CFP, 1659x2212px, acquired with a Remidio Fundus on Phone.
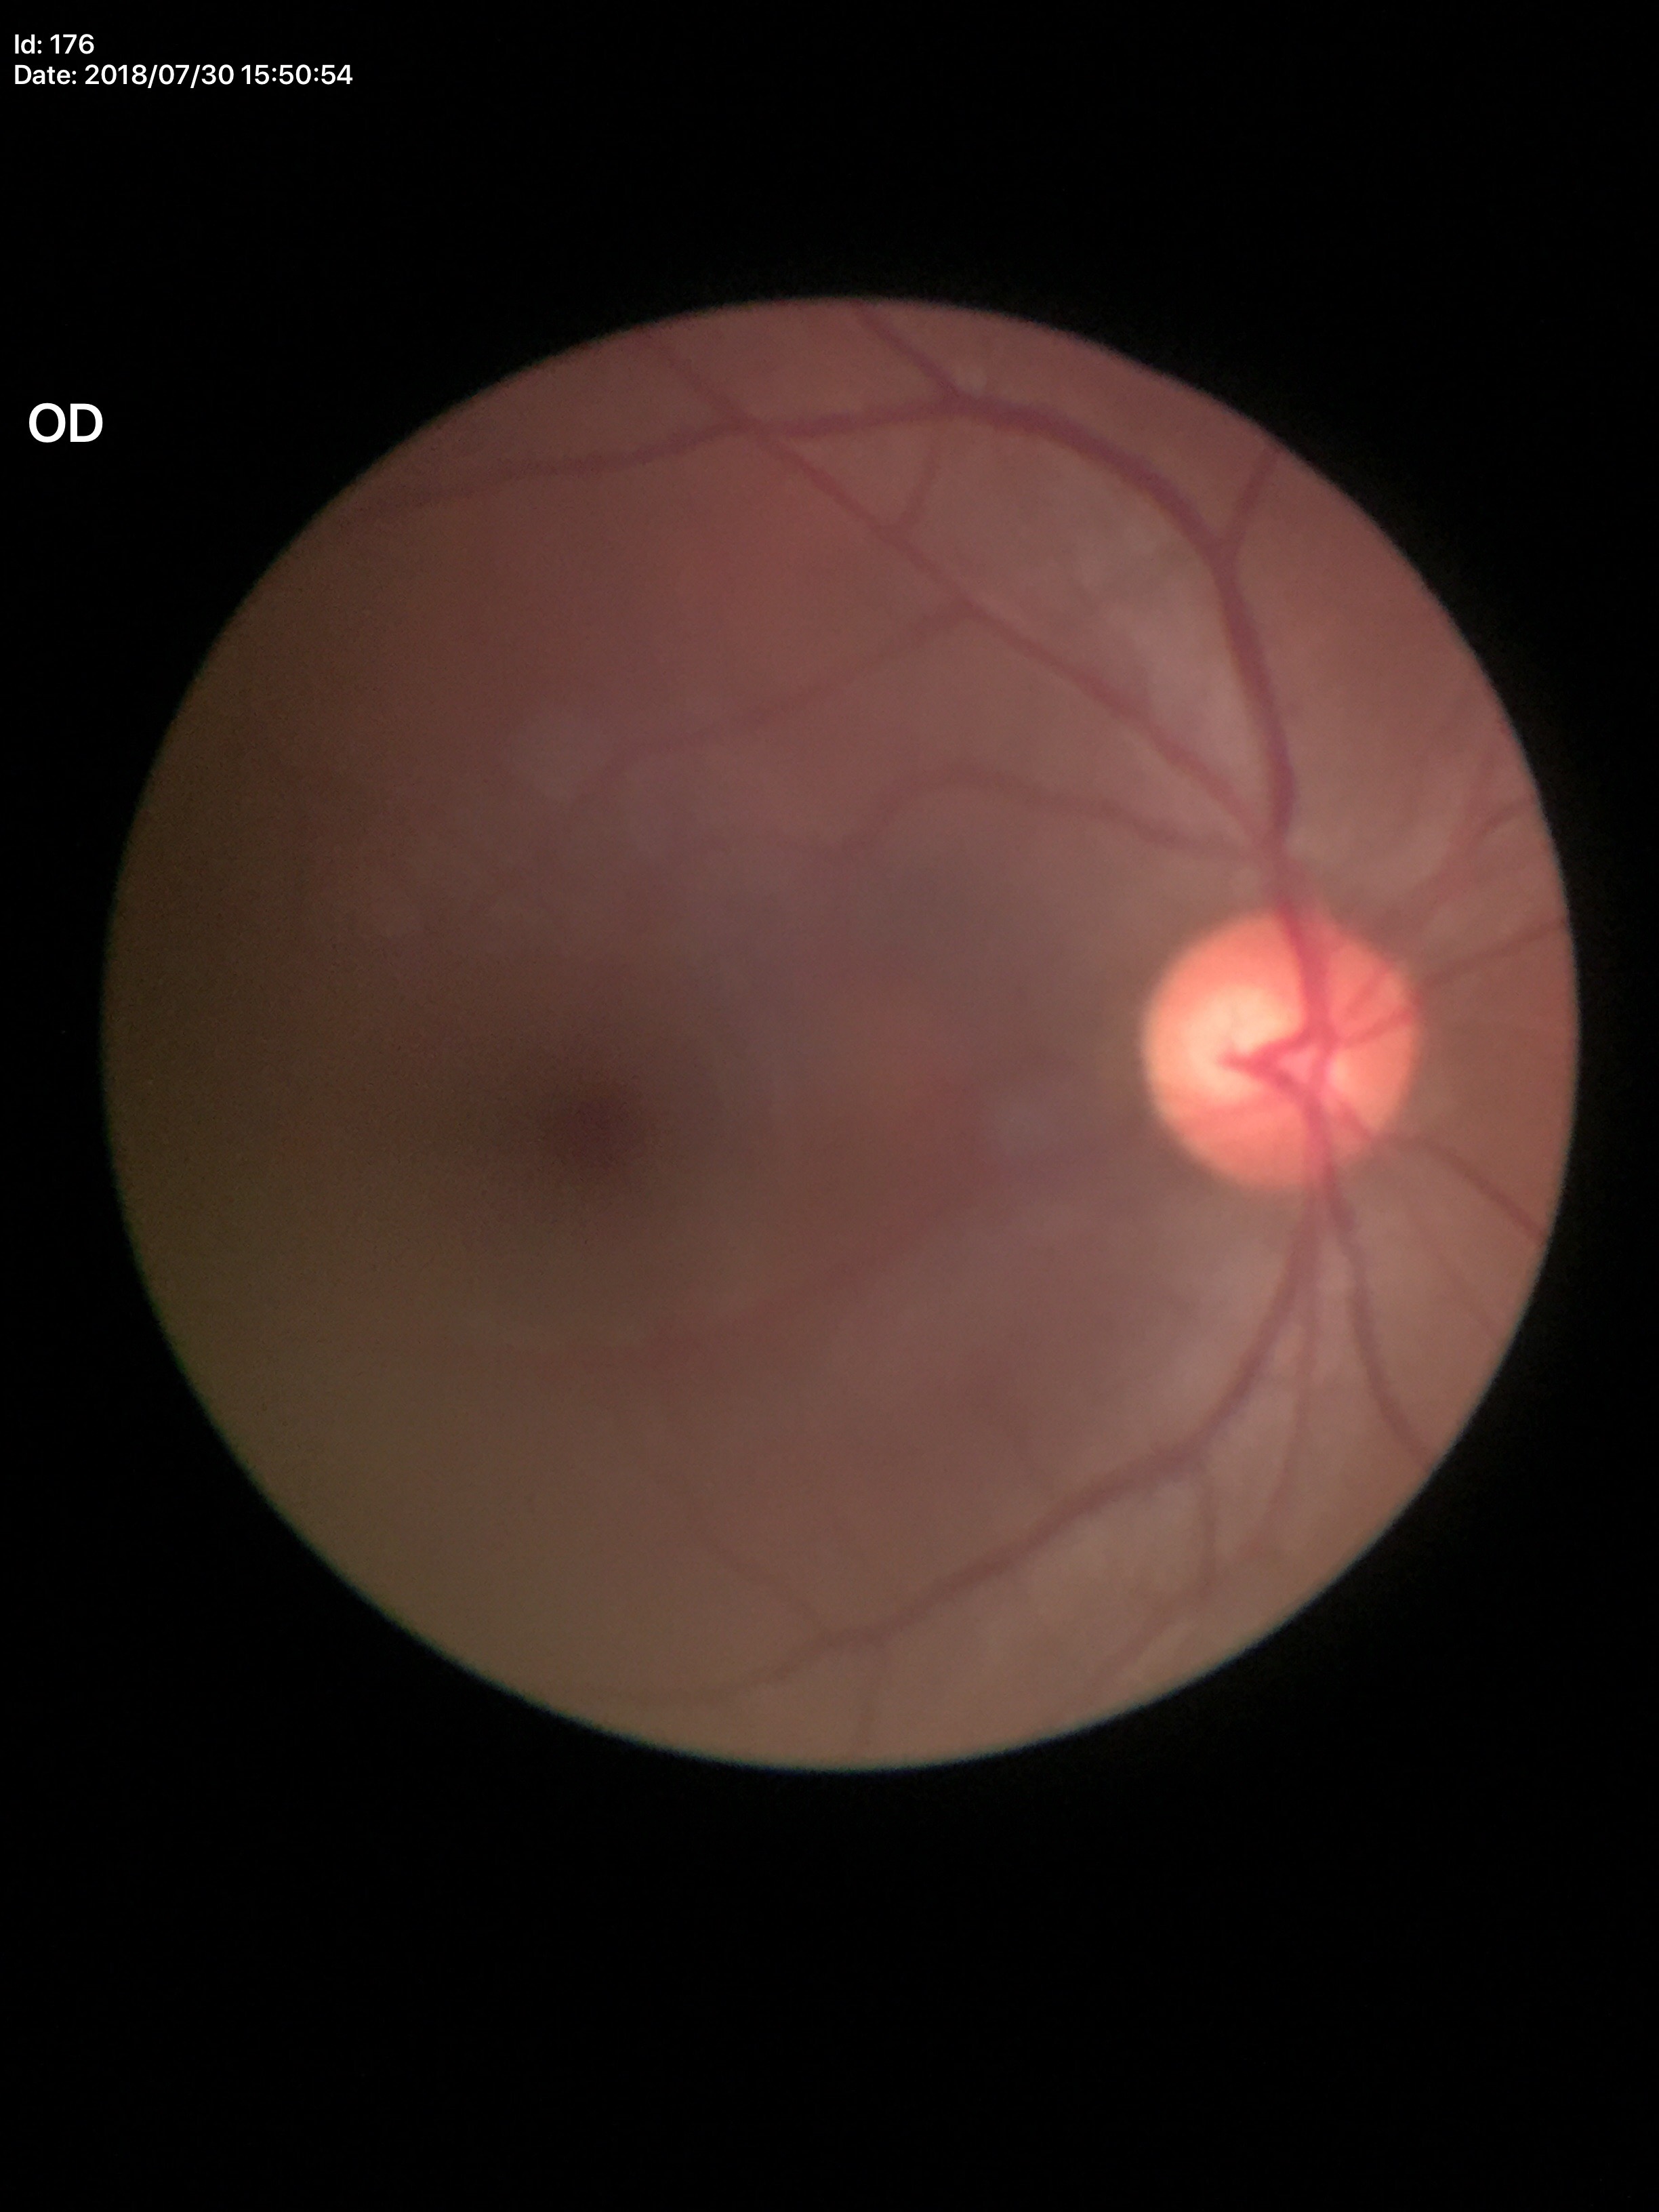
Glaucoma screening impression: negative (unanimous normal call)
vertical cup-disc ratio (VCDR): 0.55
area CDR (ACDR): 0.34